2212x1659, color fundus photograph, 45-degree field of view.
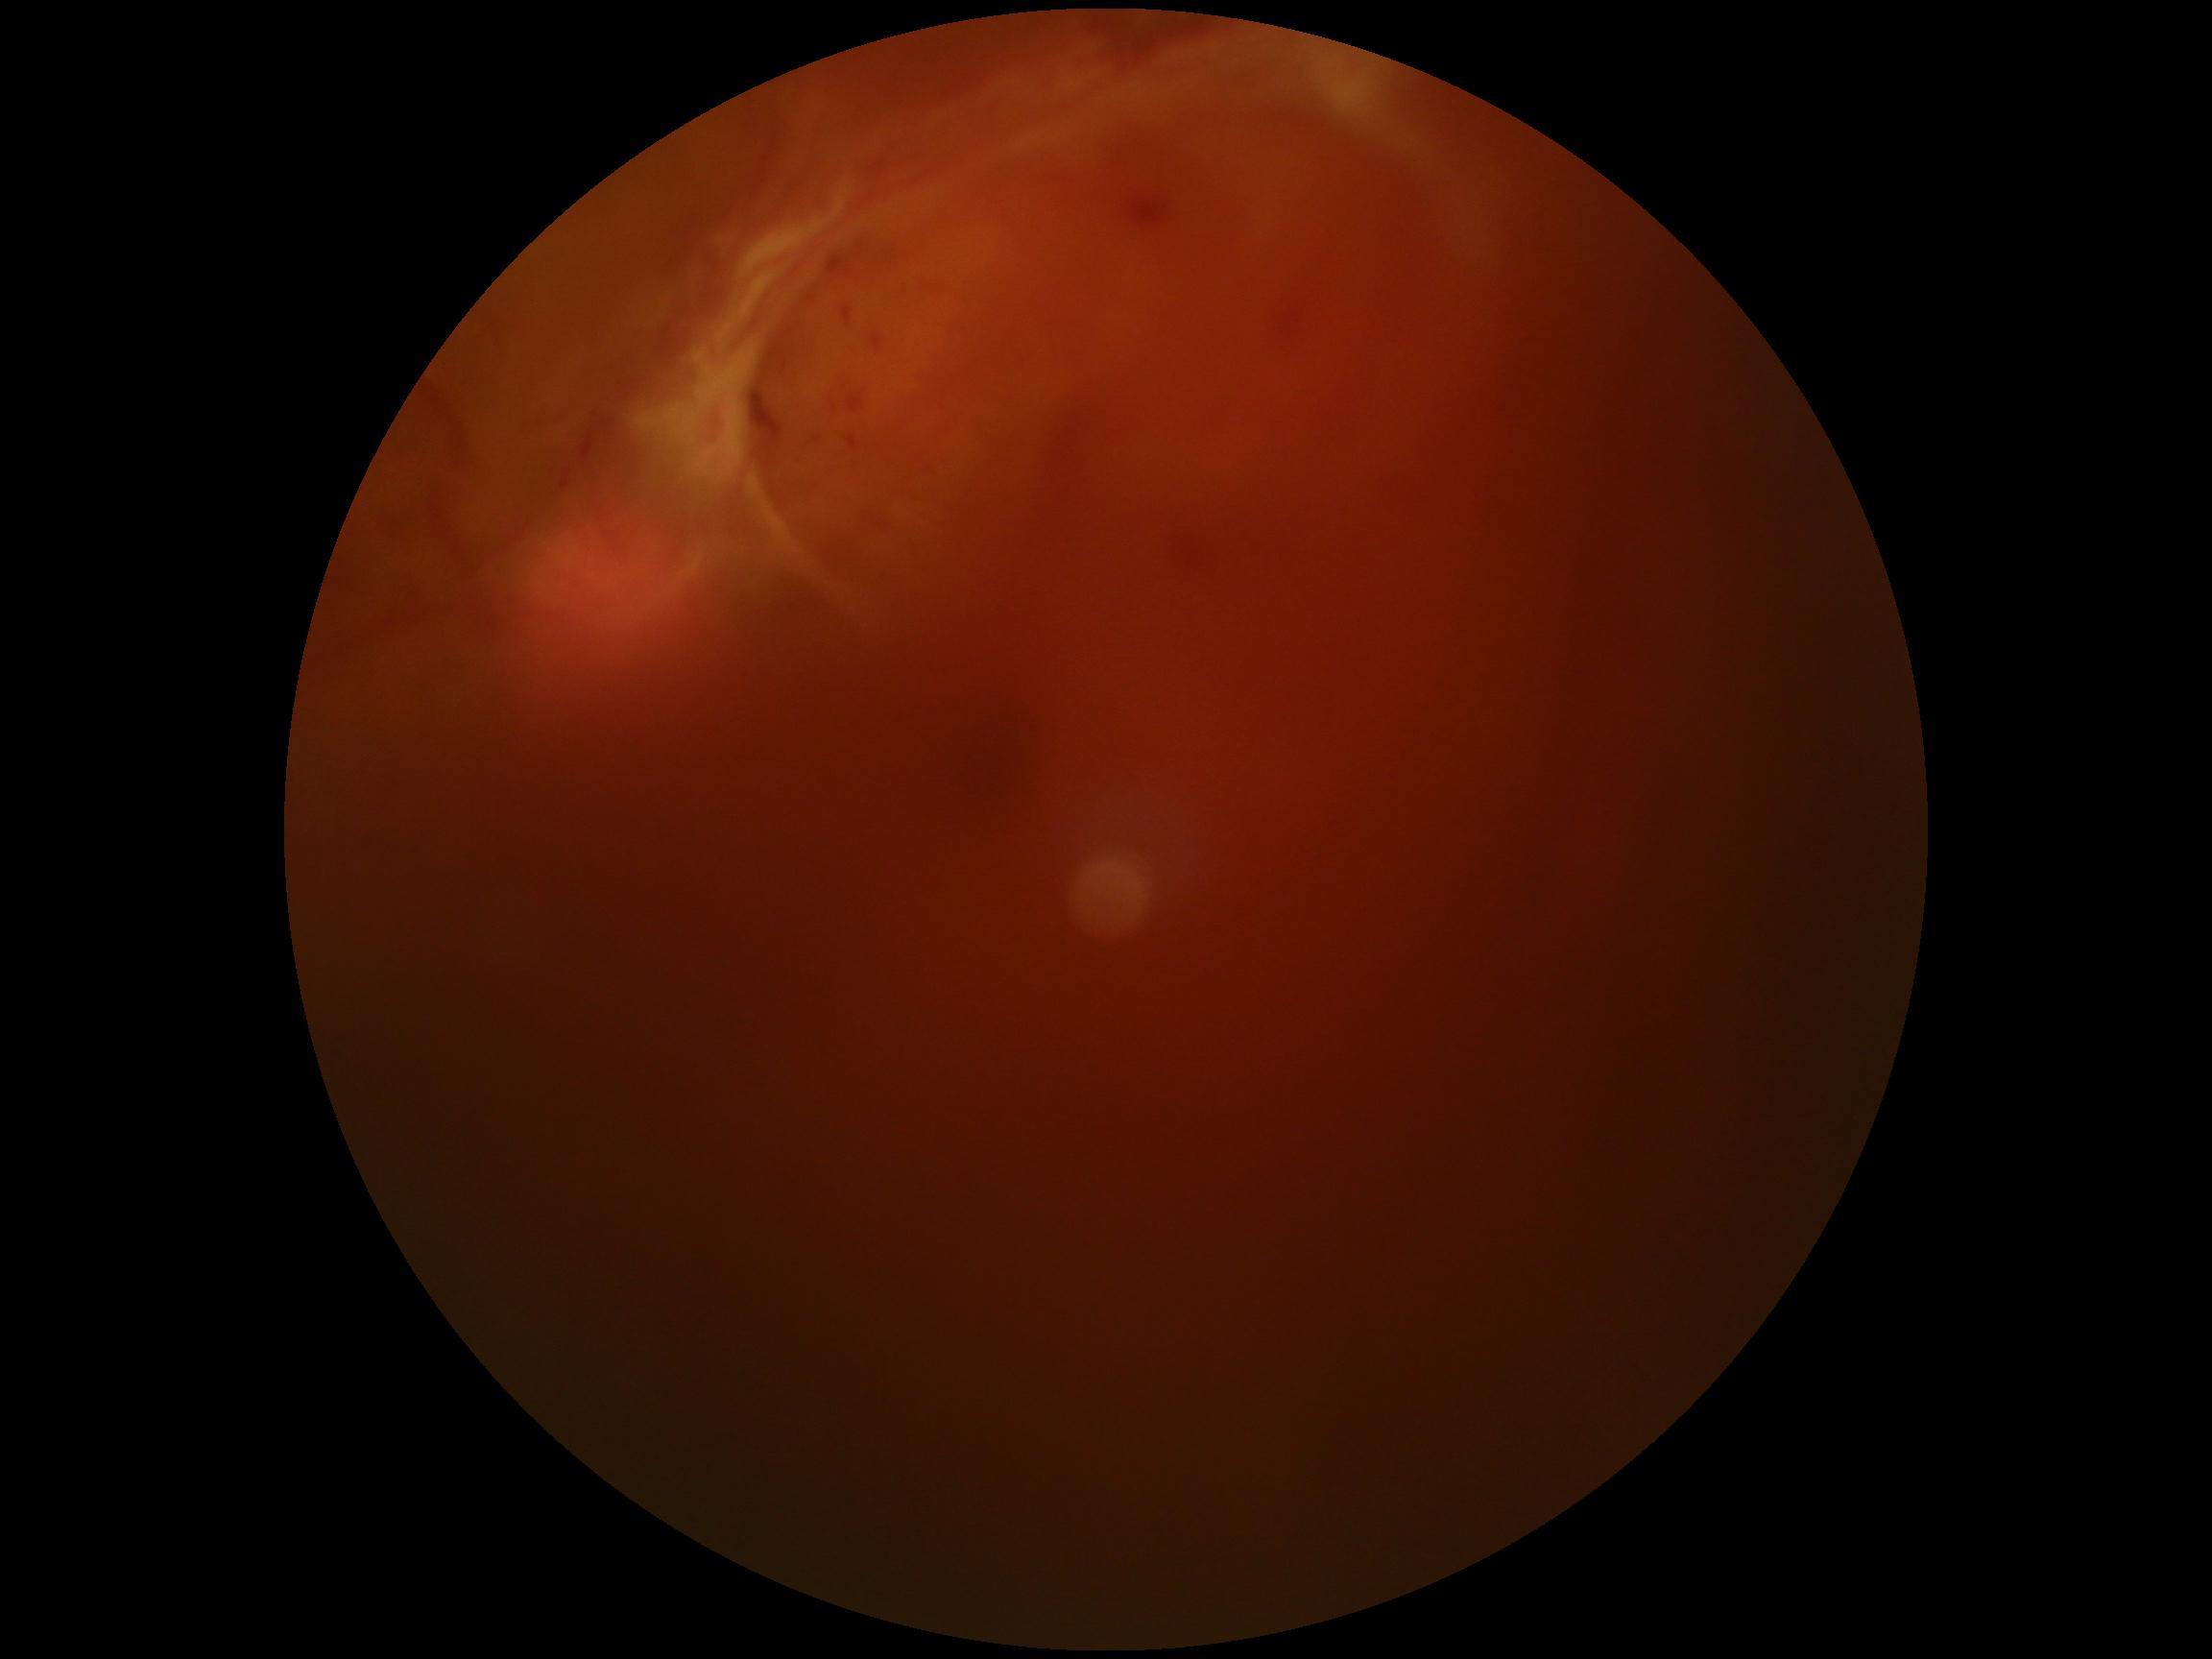 DR class: proliferative diabetic retinopathy, retinopathy: 4/4.